Acquired with a Forus 3Nethra Classic fundus camera:
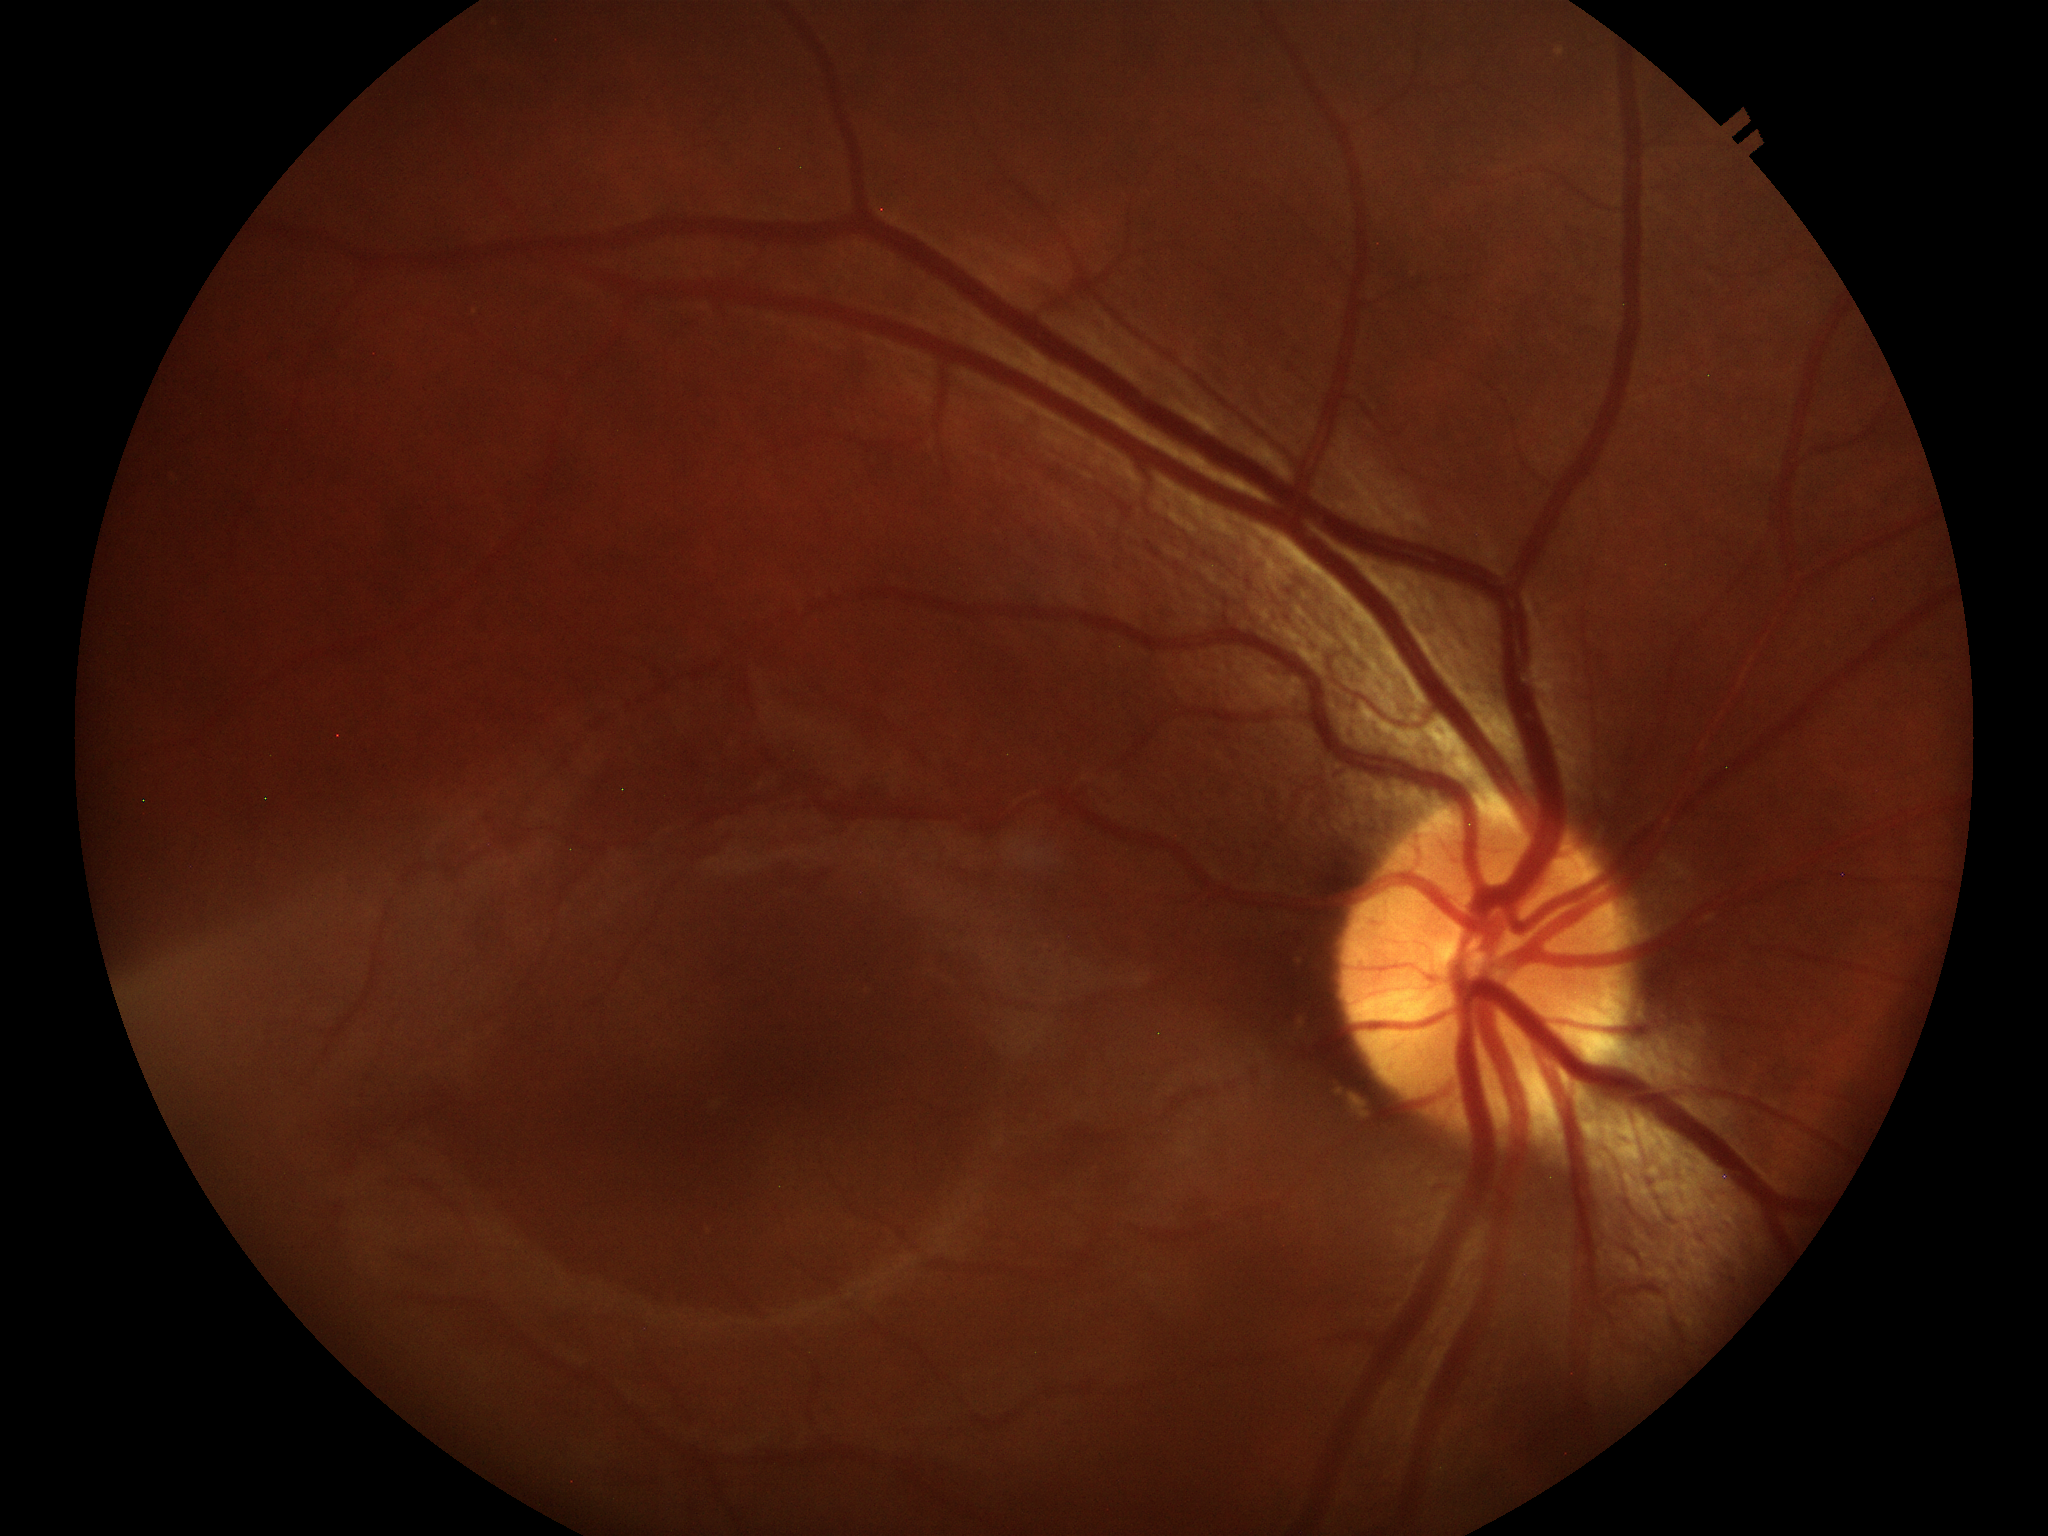

  acdr: 0.19
  vcdr: 0.48
  glaucoma_decision: negative